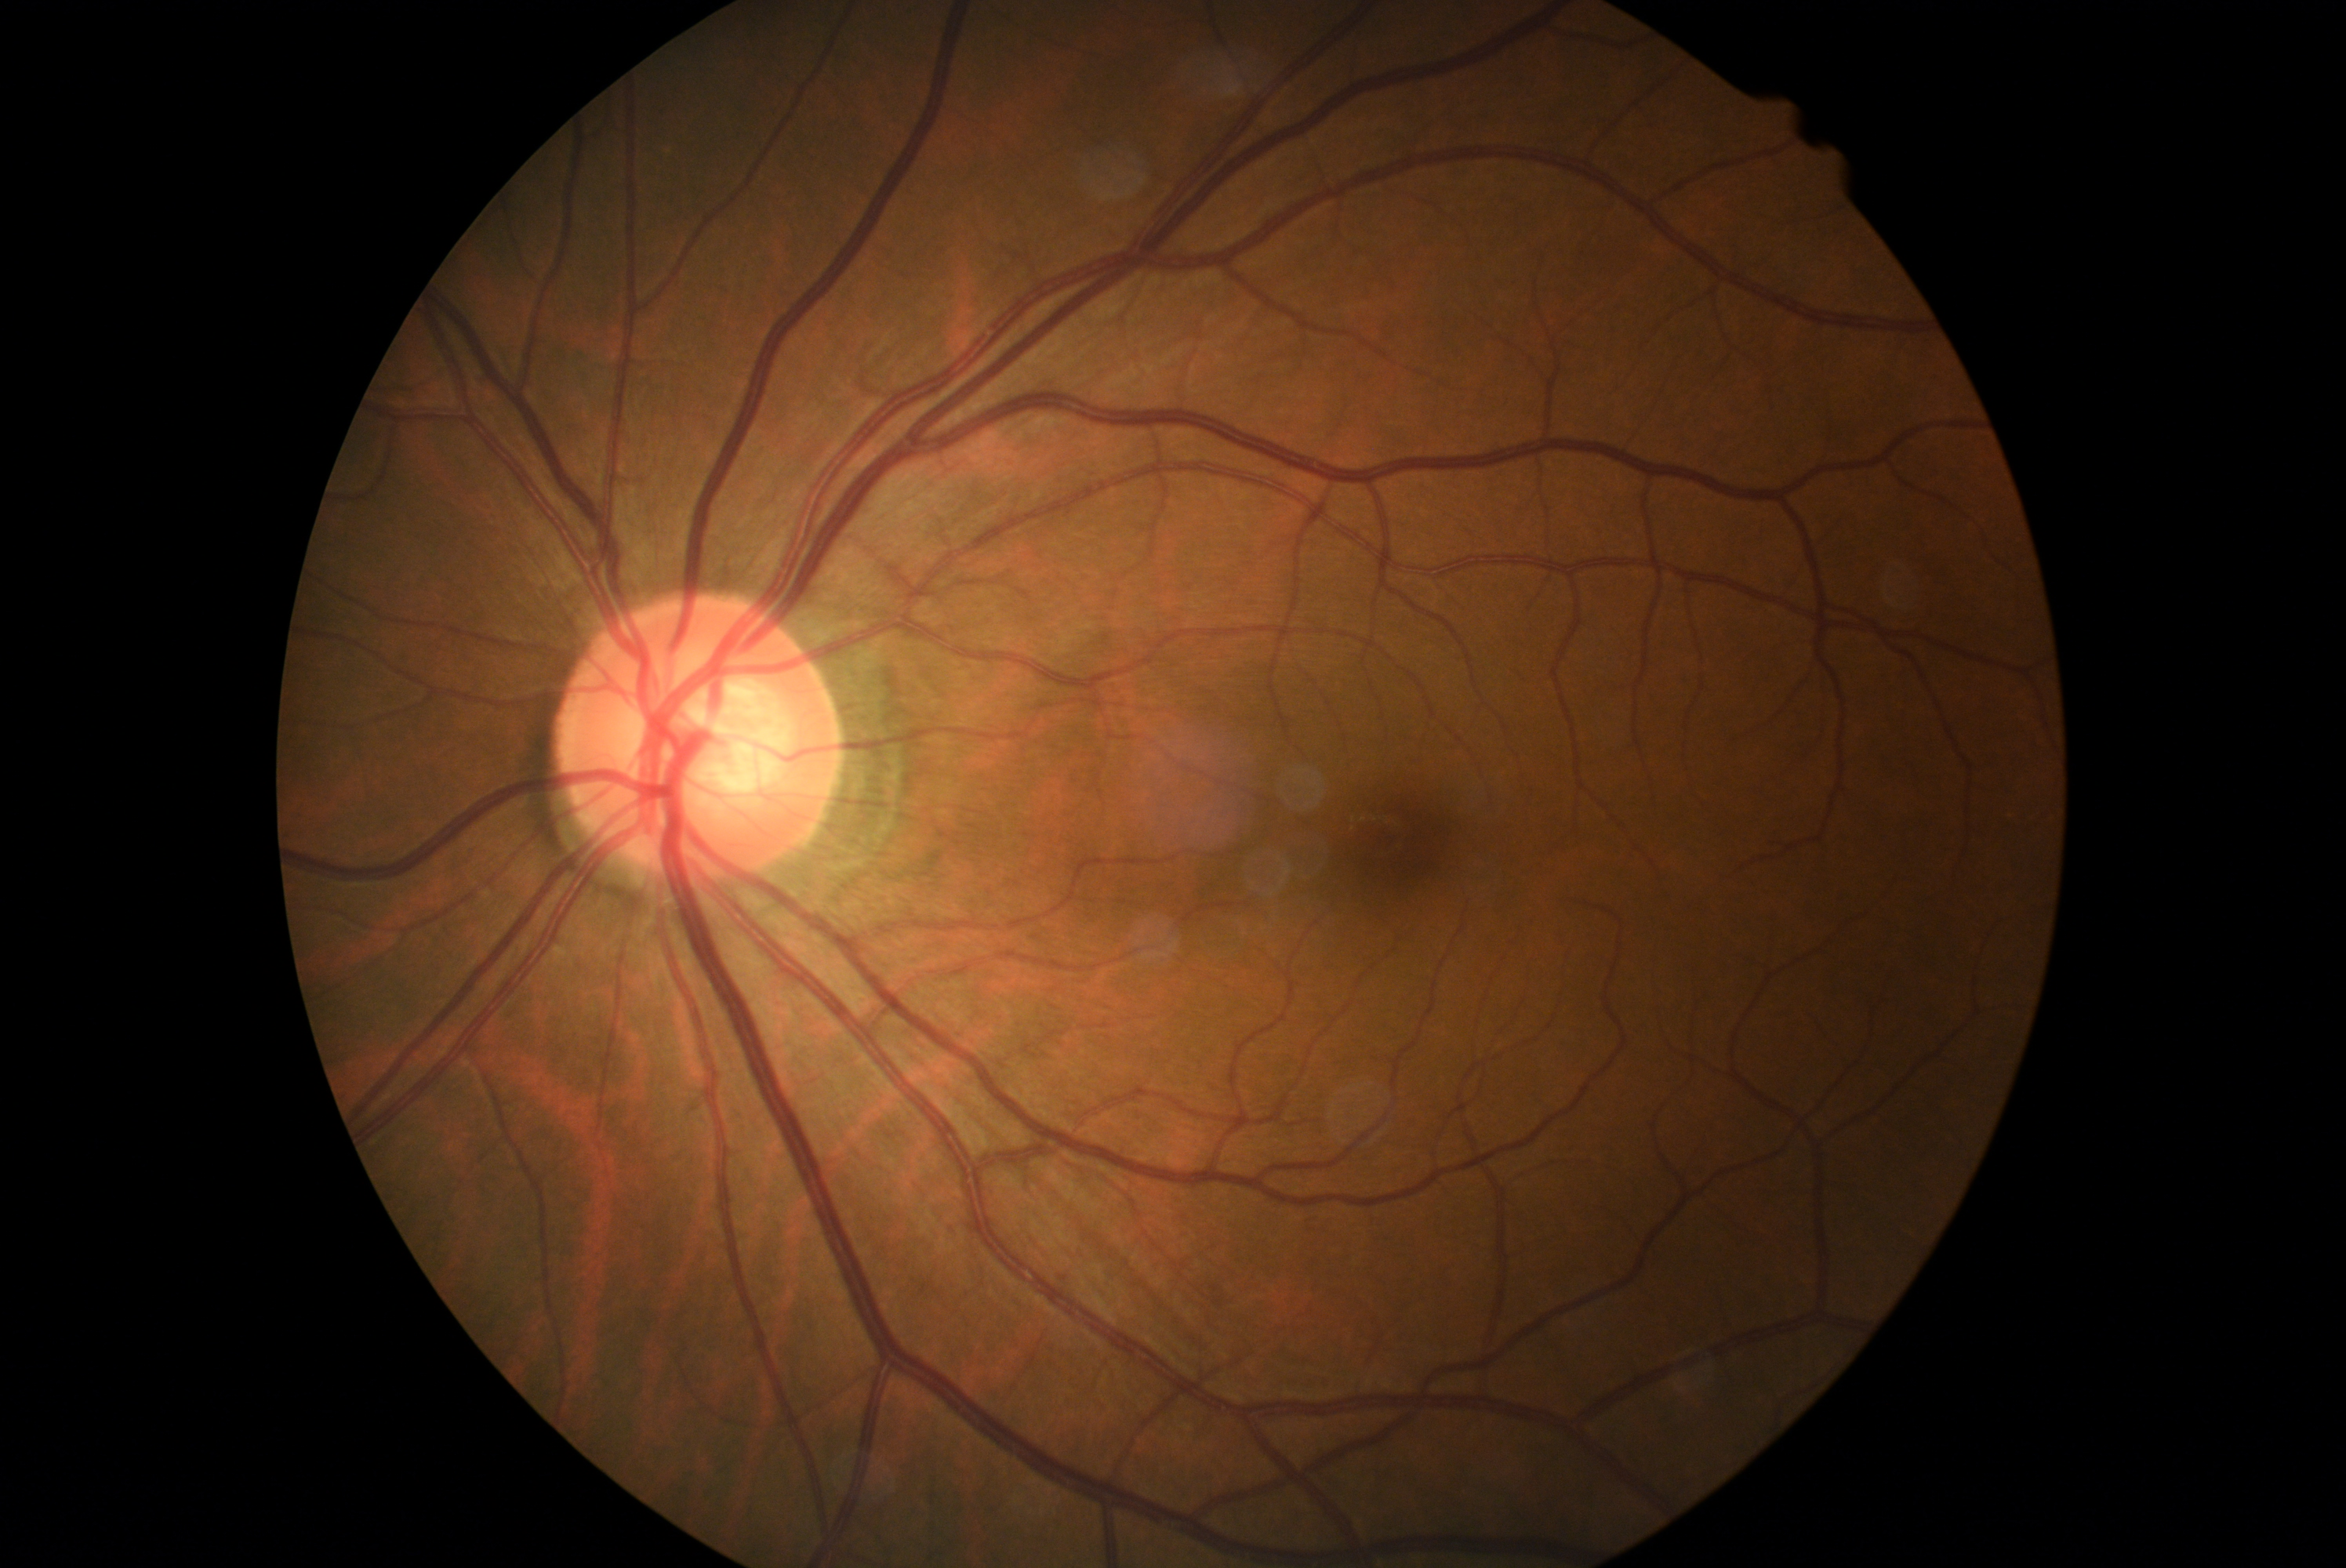

– DR grade: 0/4